45° field of view · retinal fundus photograph.
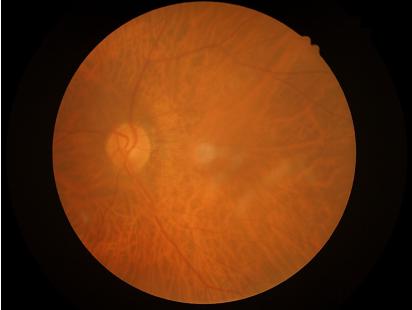

Focus: noticeable blur in the optic disc, vessels, or background; Contrast: poor dynamic range; Overall: inadequate for clinical interpretation; Illumination/color: no over- or under-exposure.